No pharmacologic dilation · 848 by 848 pixels
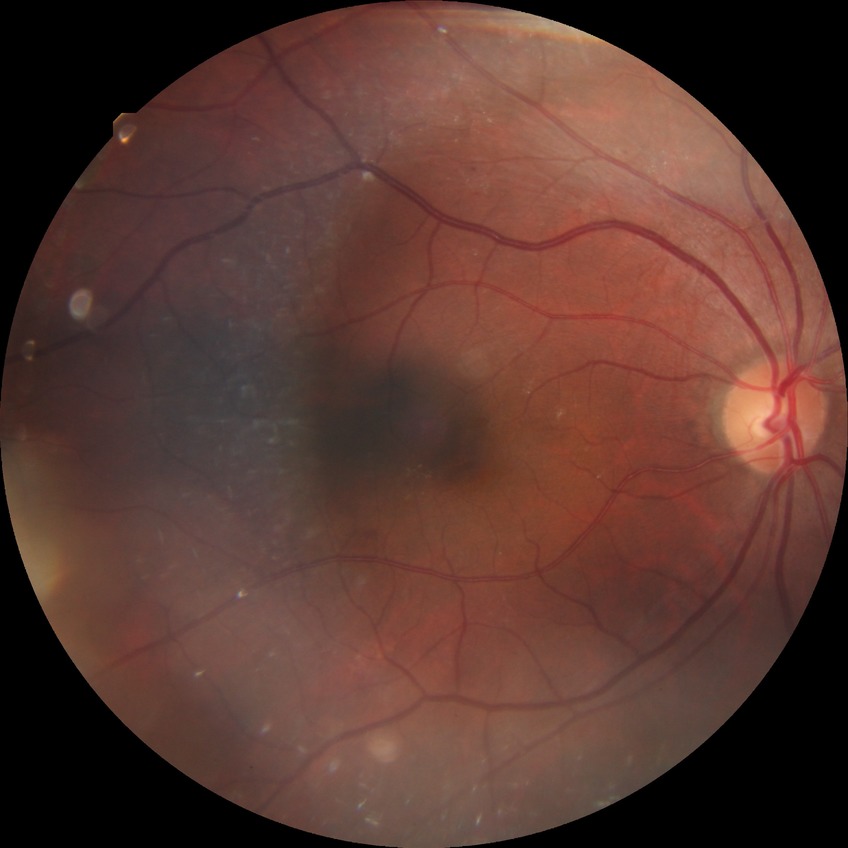

modified Davis grading: simple diabetic retinopathy.